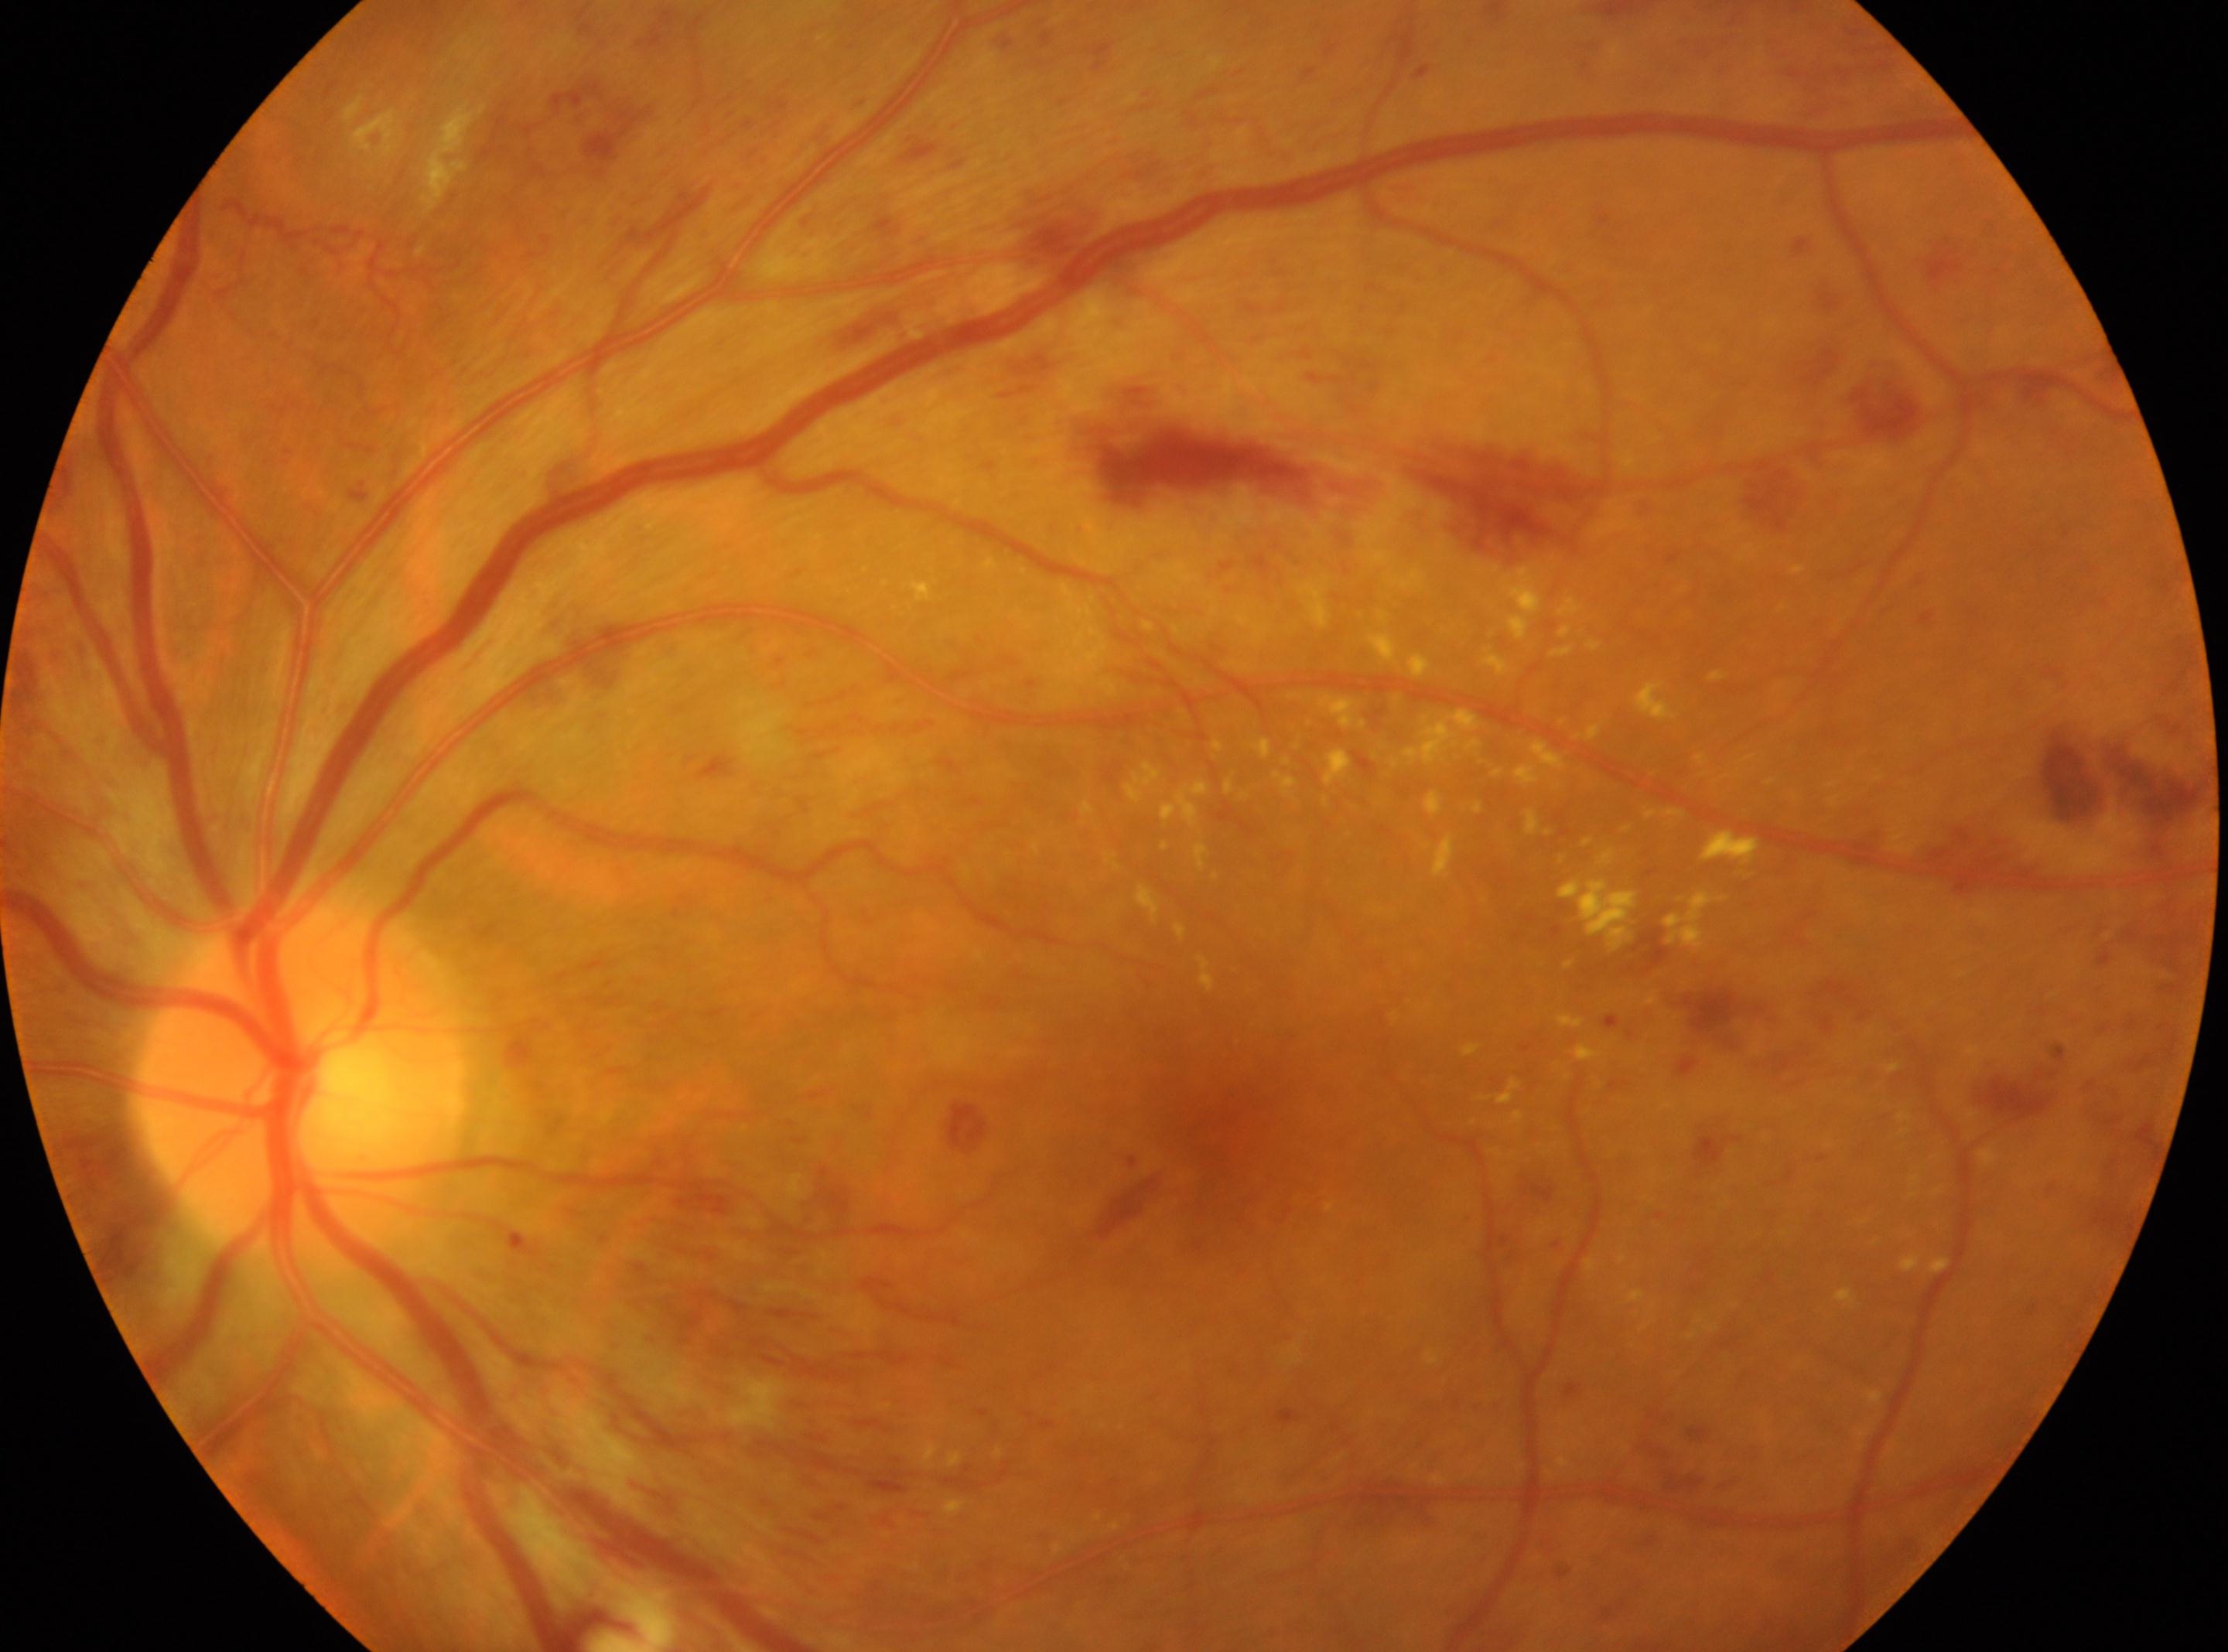

Eye: the left eye. Foveal center located at (x: 1196, y: 1115). Diabetic retinopathy severity is 3. The optic nerve head is at (x: 300, y: 1077).